2228x1652, 50° FOV.
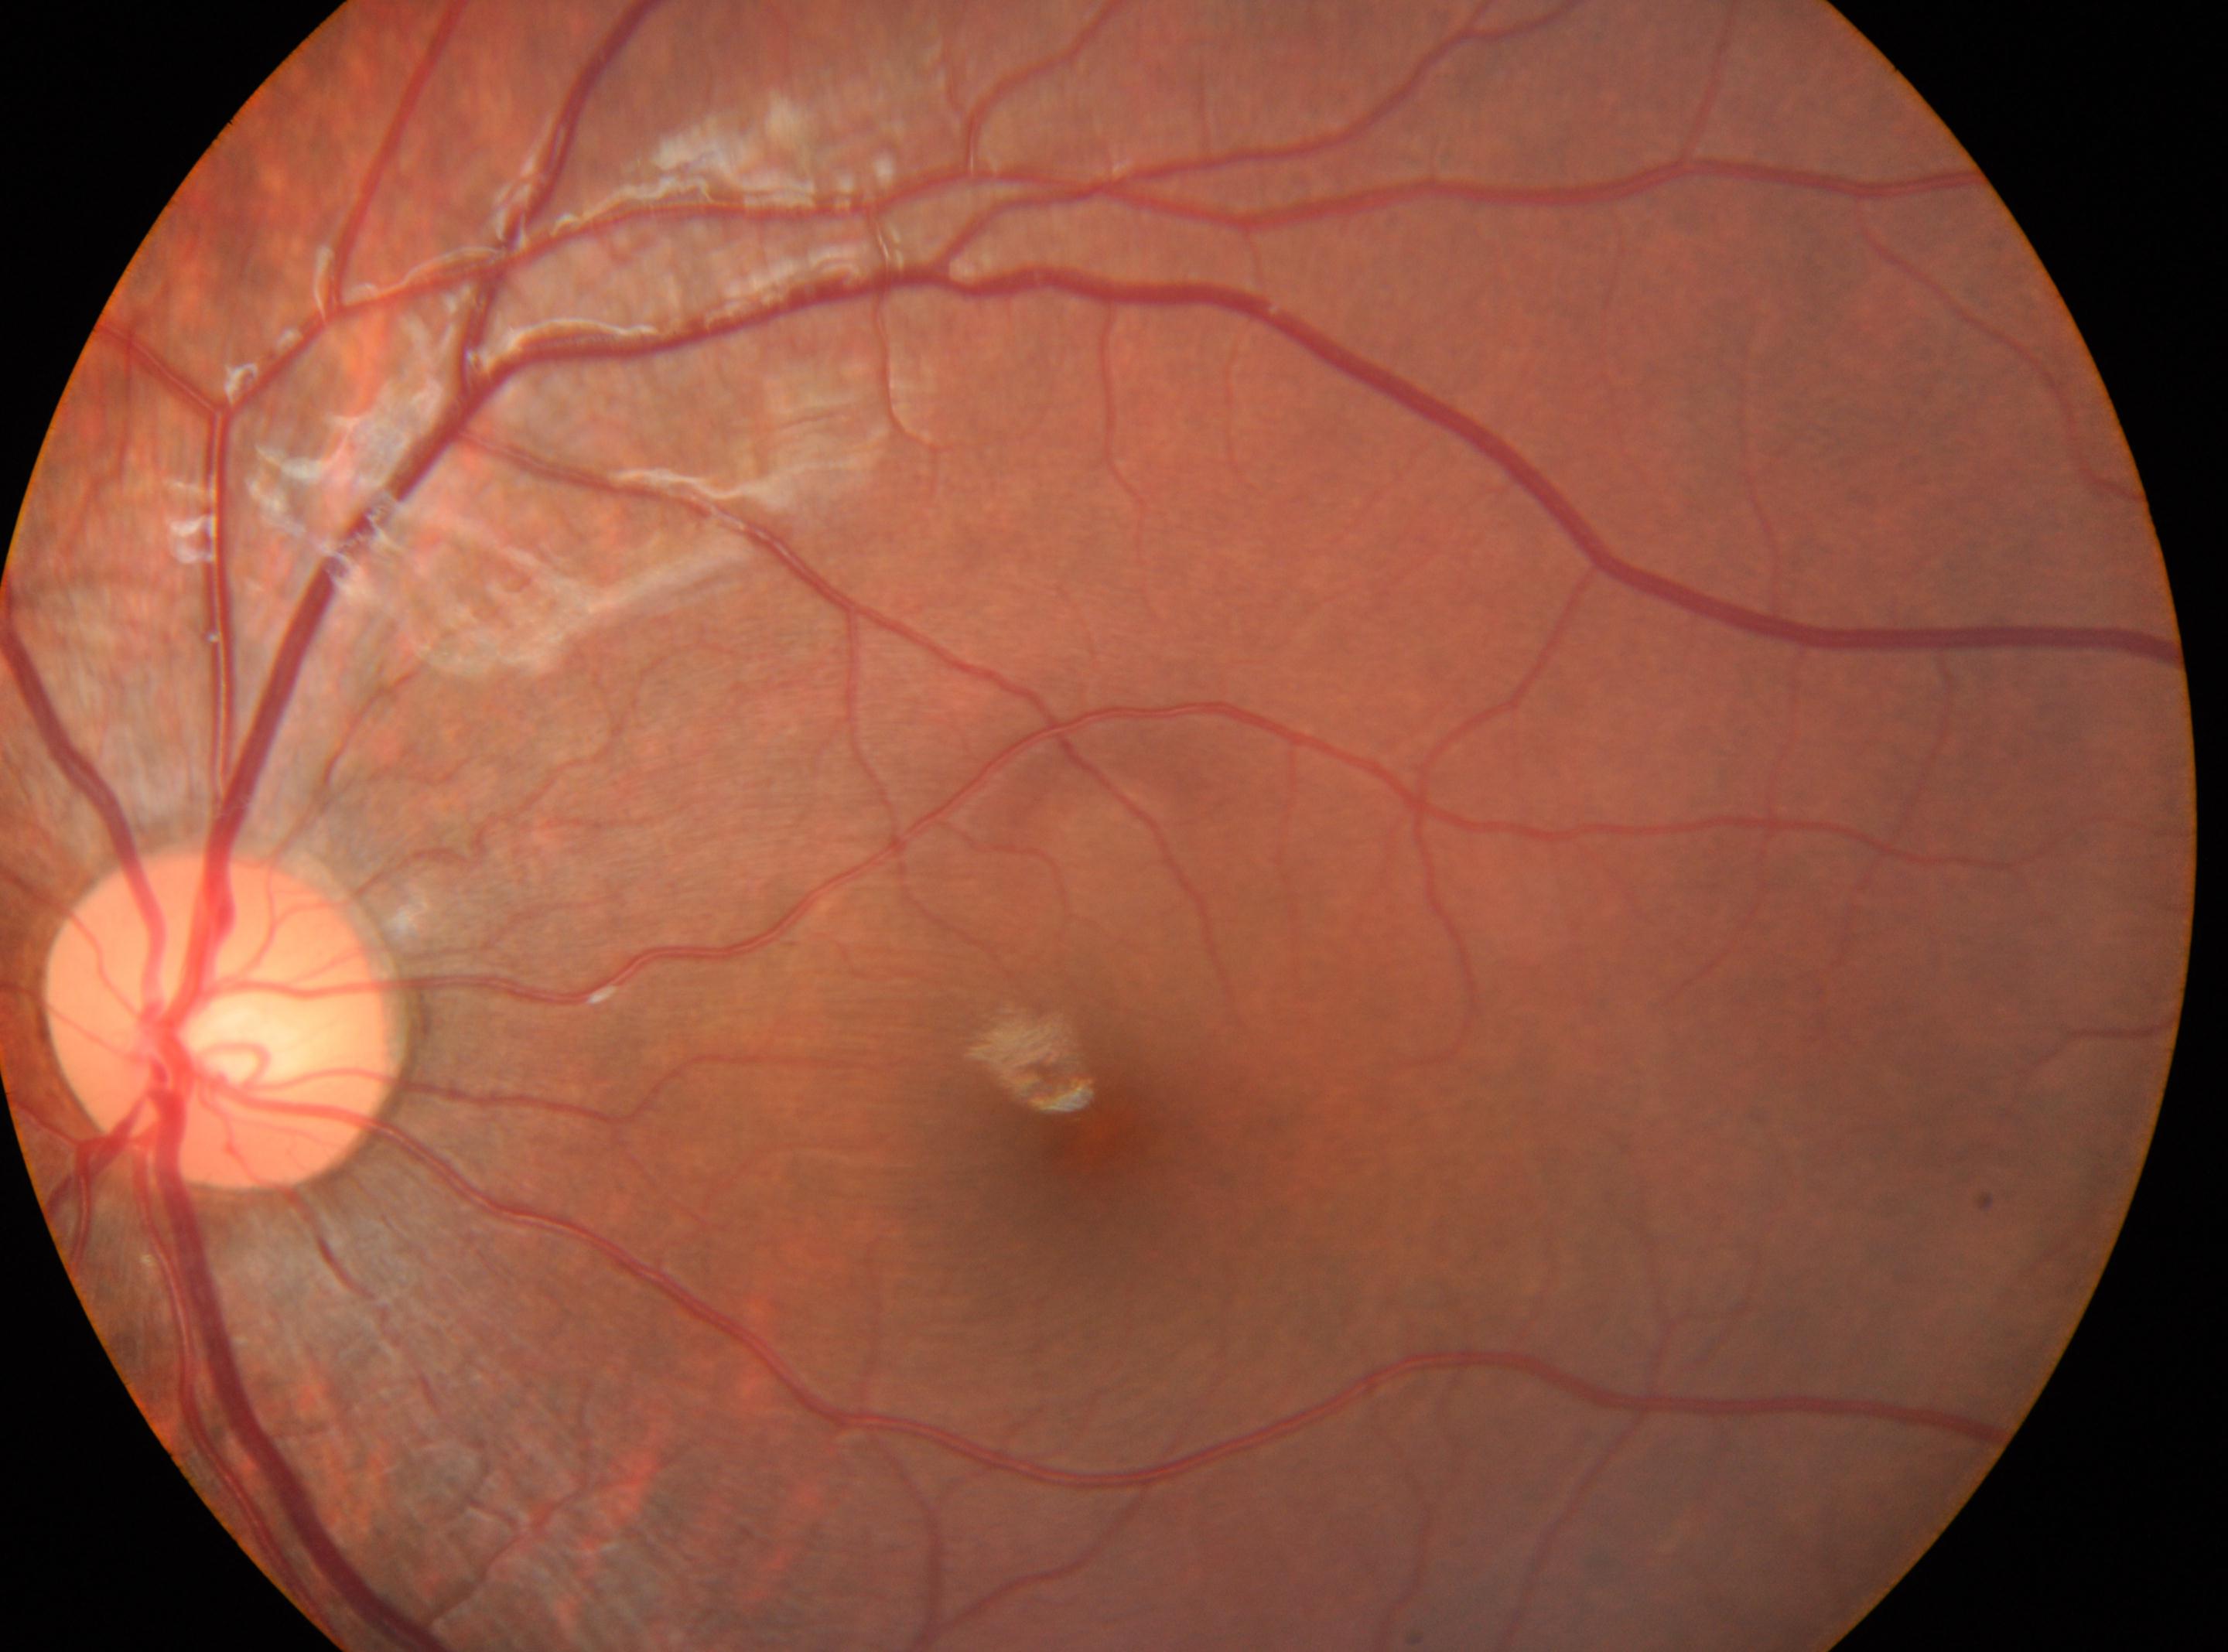

Diabetic retinopathy (DR) is grade 0 (no apparent retinopathy).
The fovea is at [1089, 1142].
This is the left eye.
Optic disc: [217, 1021].